Undilated pupil. Sex: F. Axial length: 22.18 mm. Age 78. Intraocular pressure (IOP) 15 mmHg
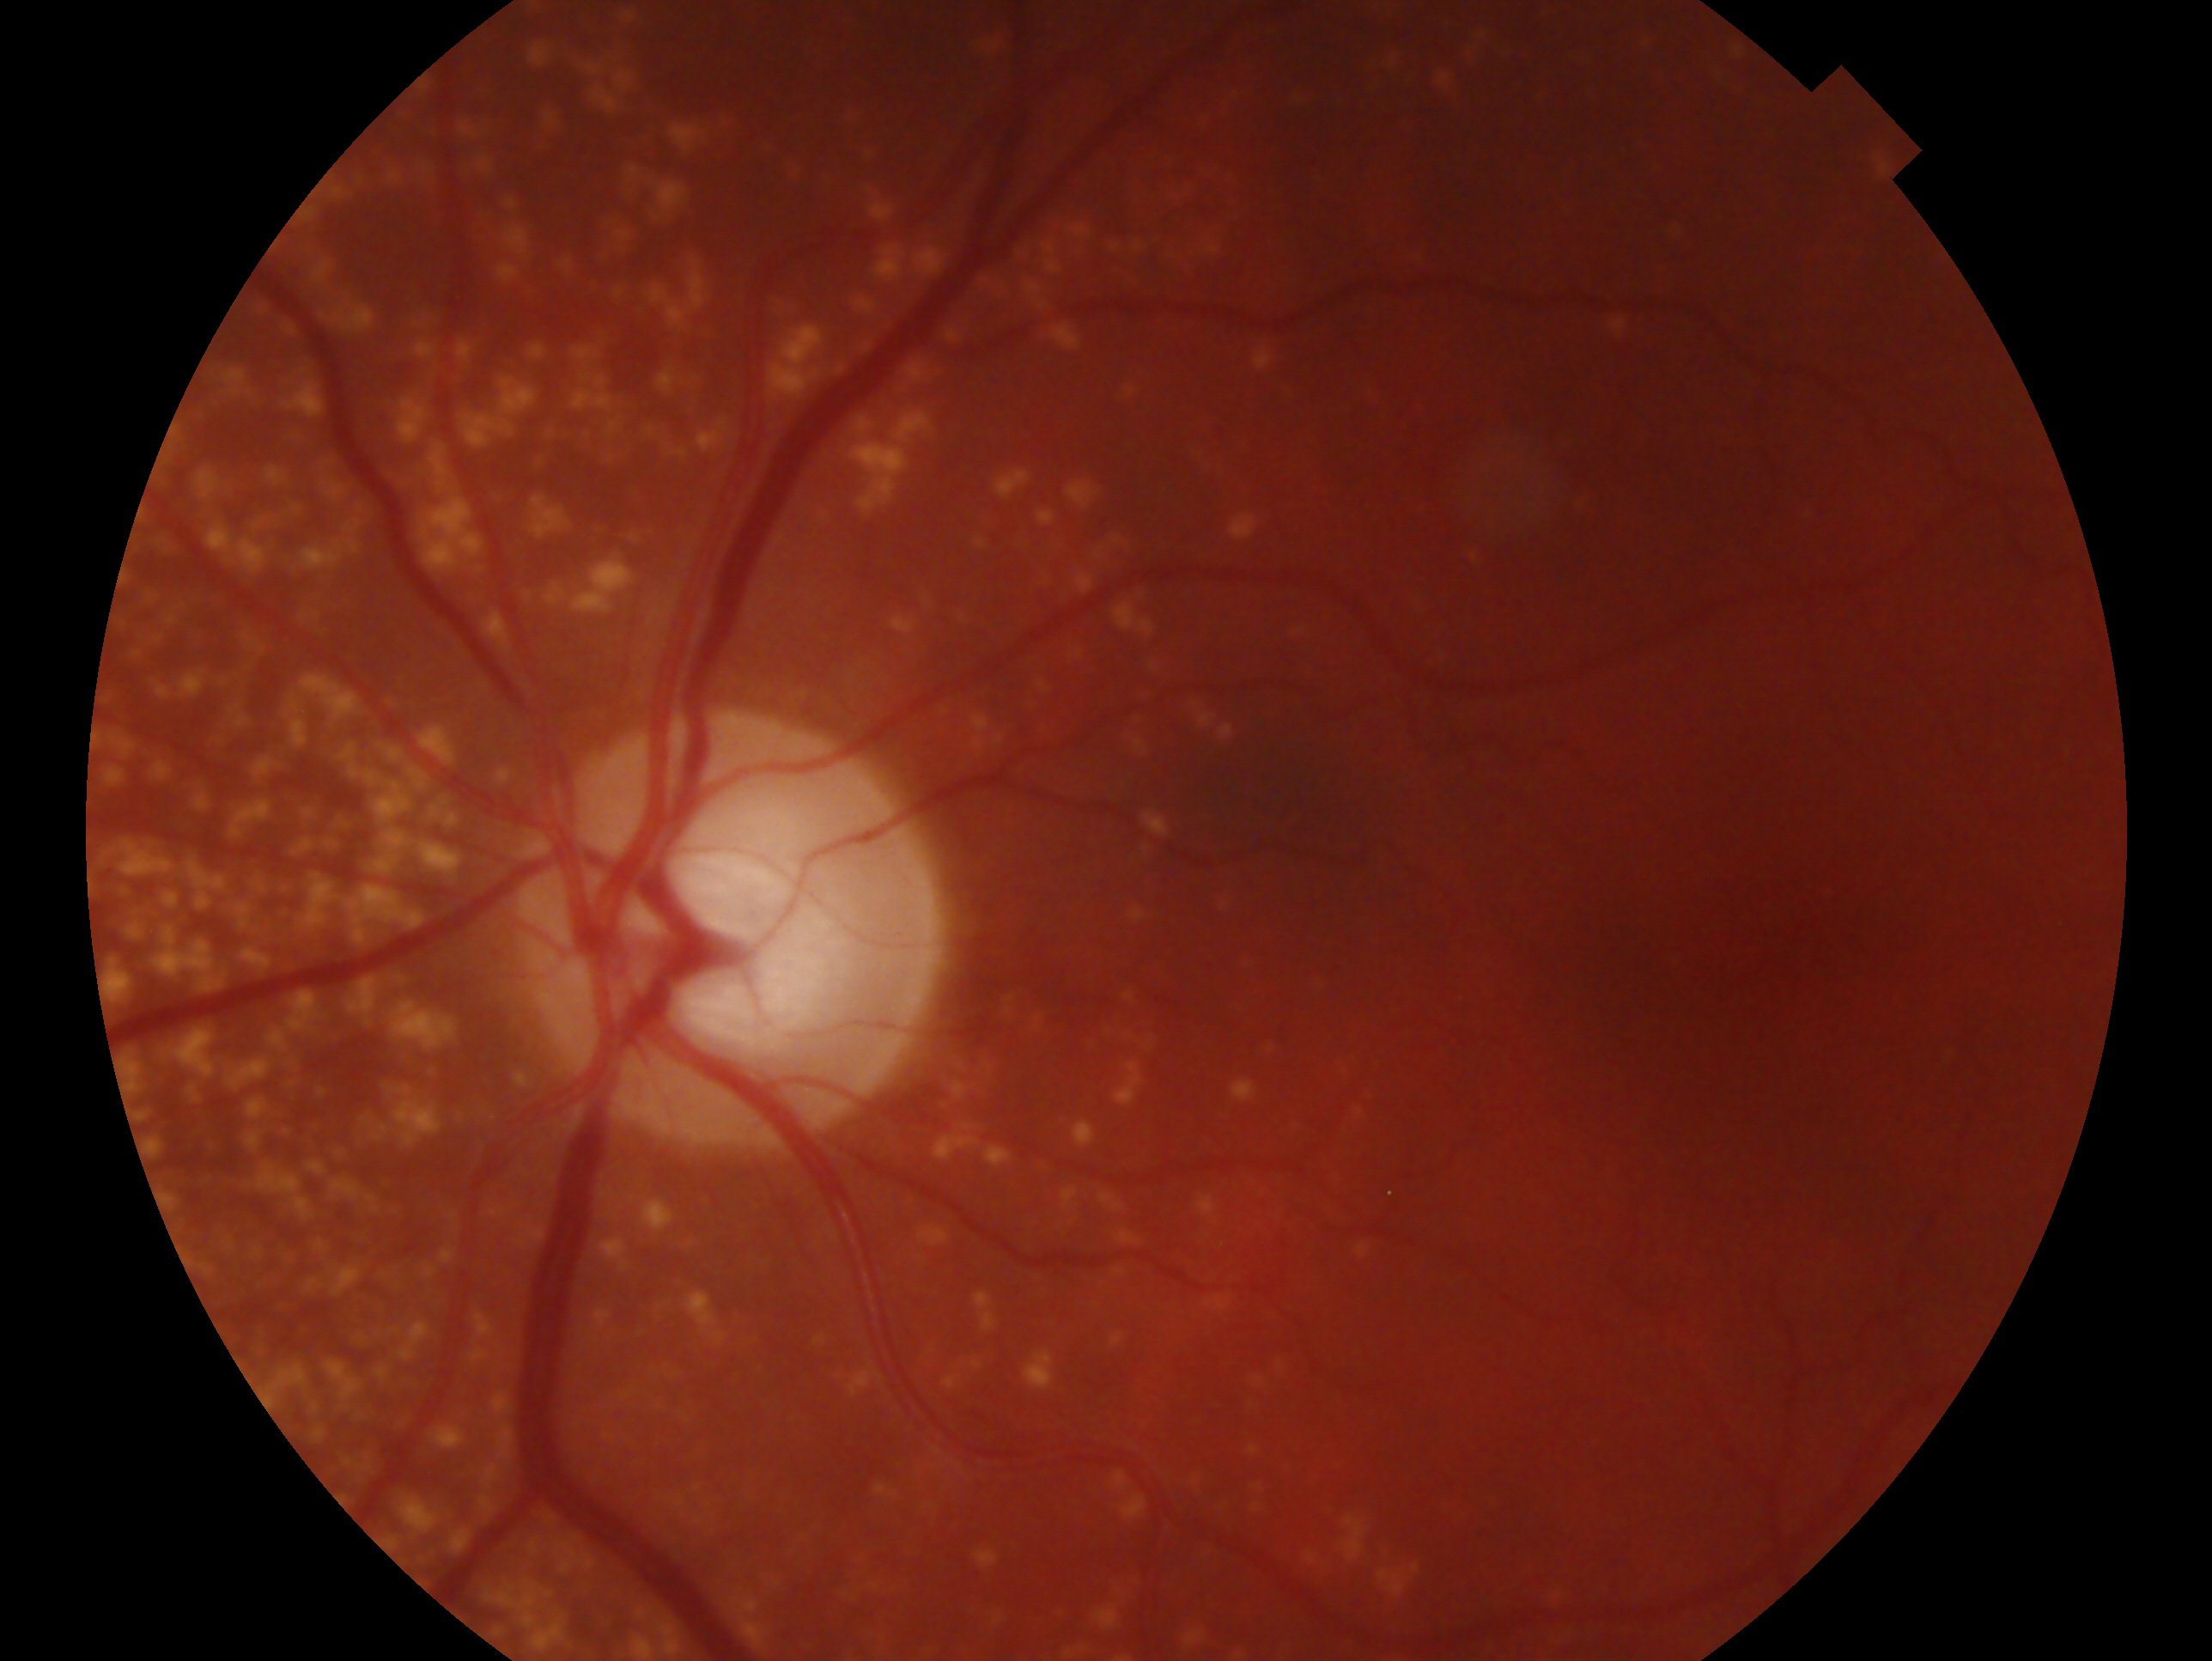

eye: left eye
glaucoma_dx: consistent with glaucoma